2352 by 1568 pixels. CFP
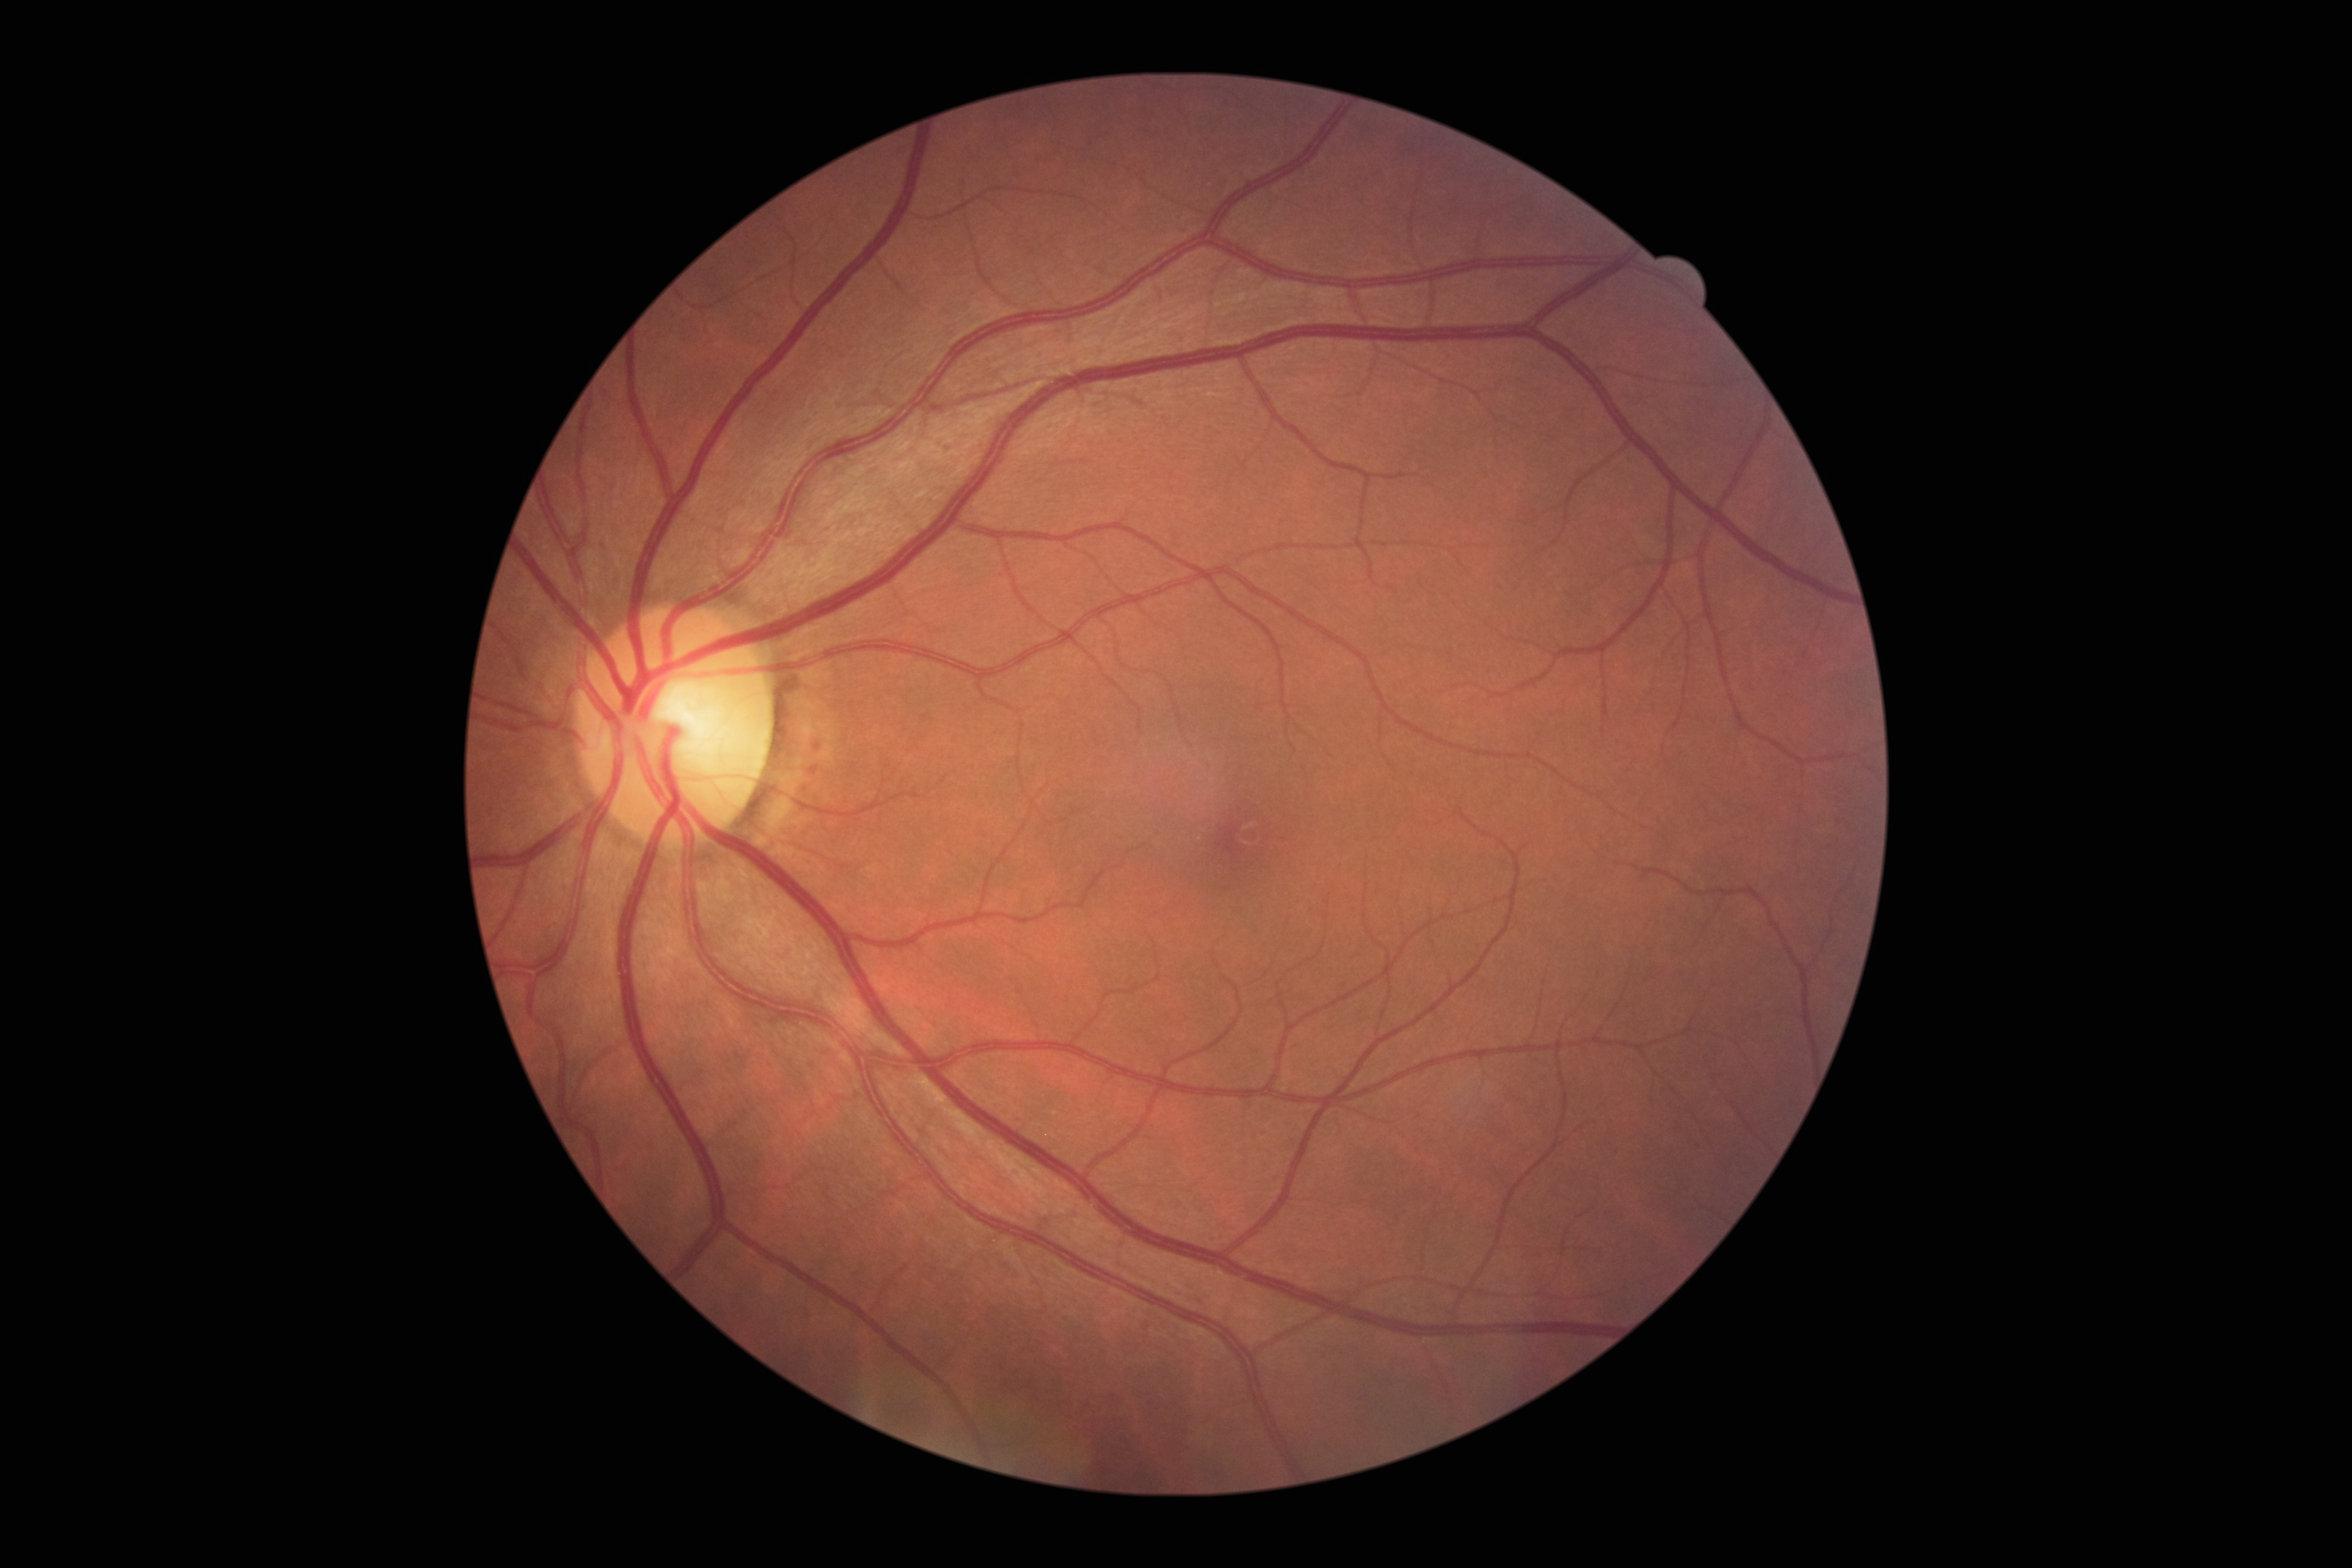 DR severity is 0/4.